Posterior pole view; camera: Topcon TRC-50DX; color fundus image: 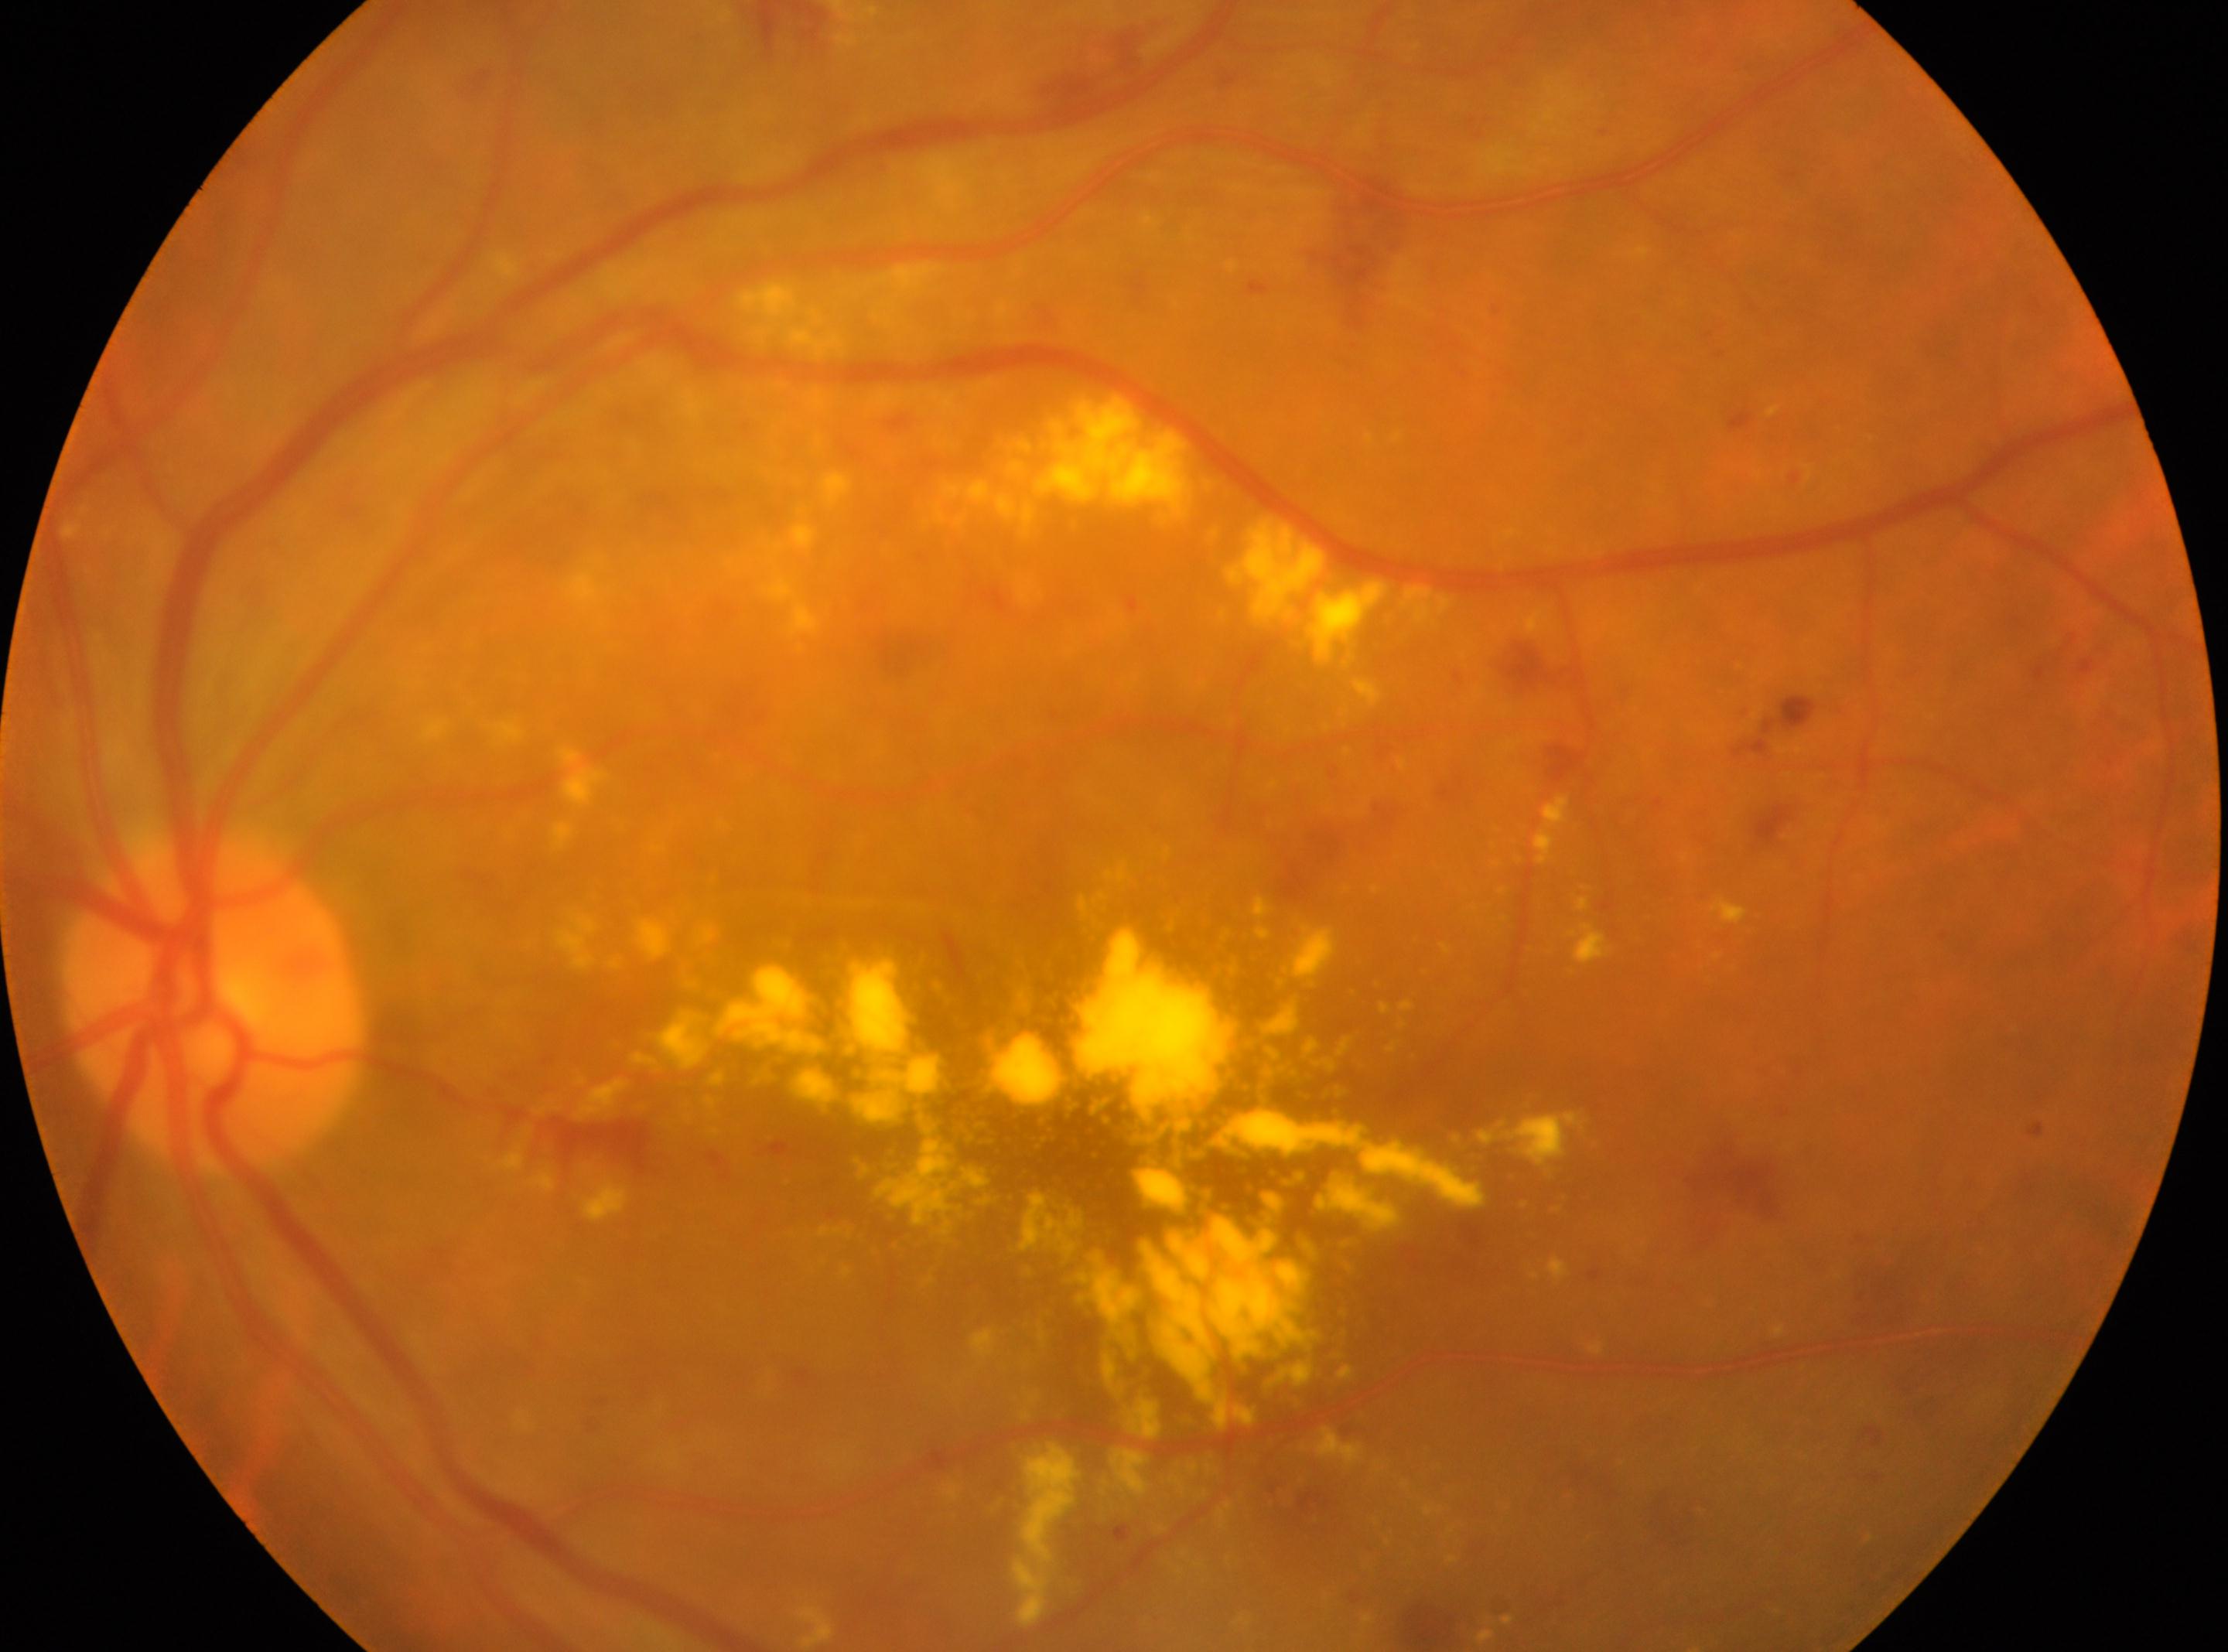
The macula center is at (x: 1100, y: 1179).
Optic disc located at (x: 214, y: 1007).
Diabetic retinopathy severity is 2.
Disease class: non-proliferative diabetic retinopathy.
This is the left eye.